Infant wide-field retinal image — 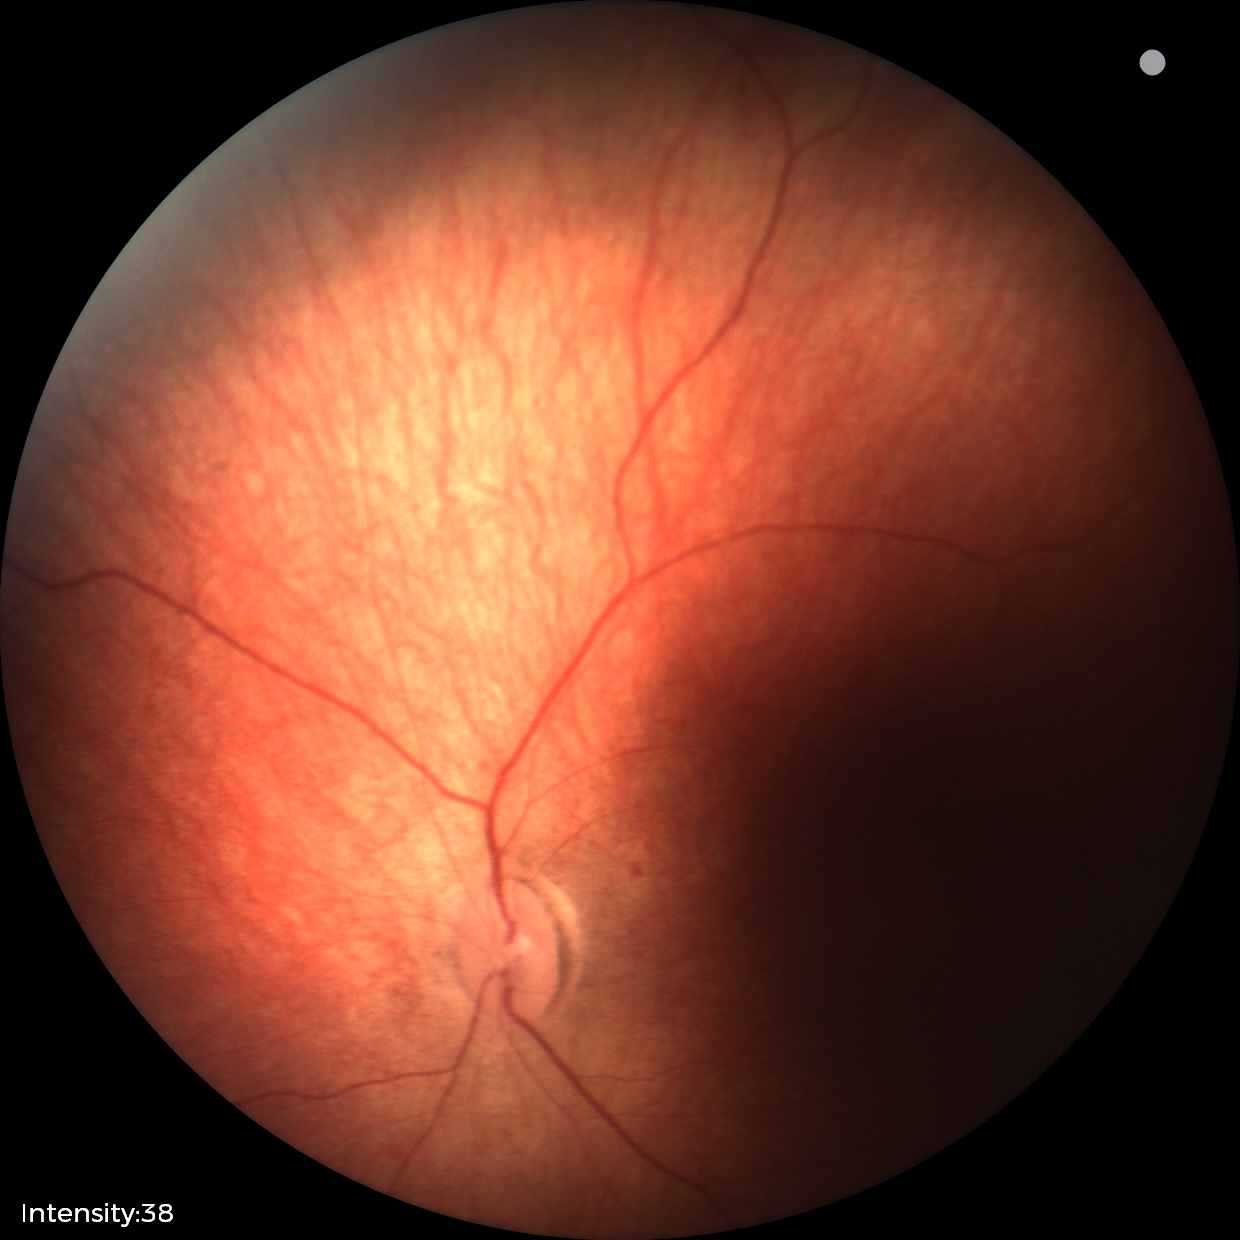
Q: What is the diagnosis from this examination?
A: normal retinal appearance